FOV: 45 degrees.
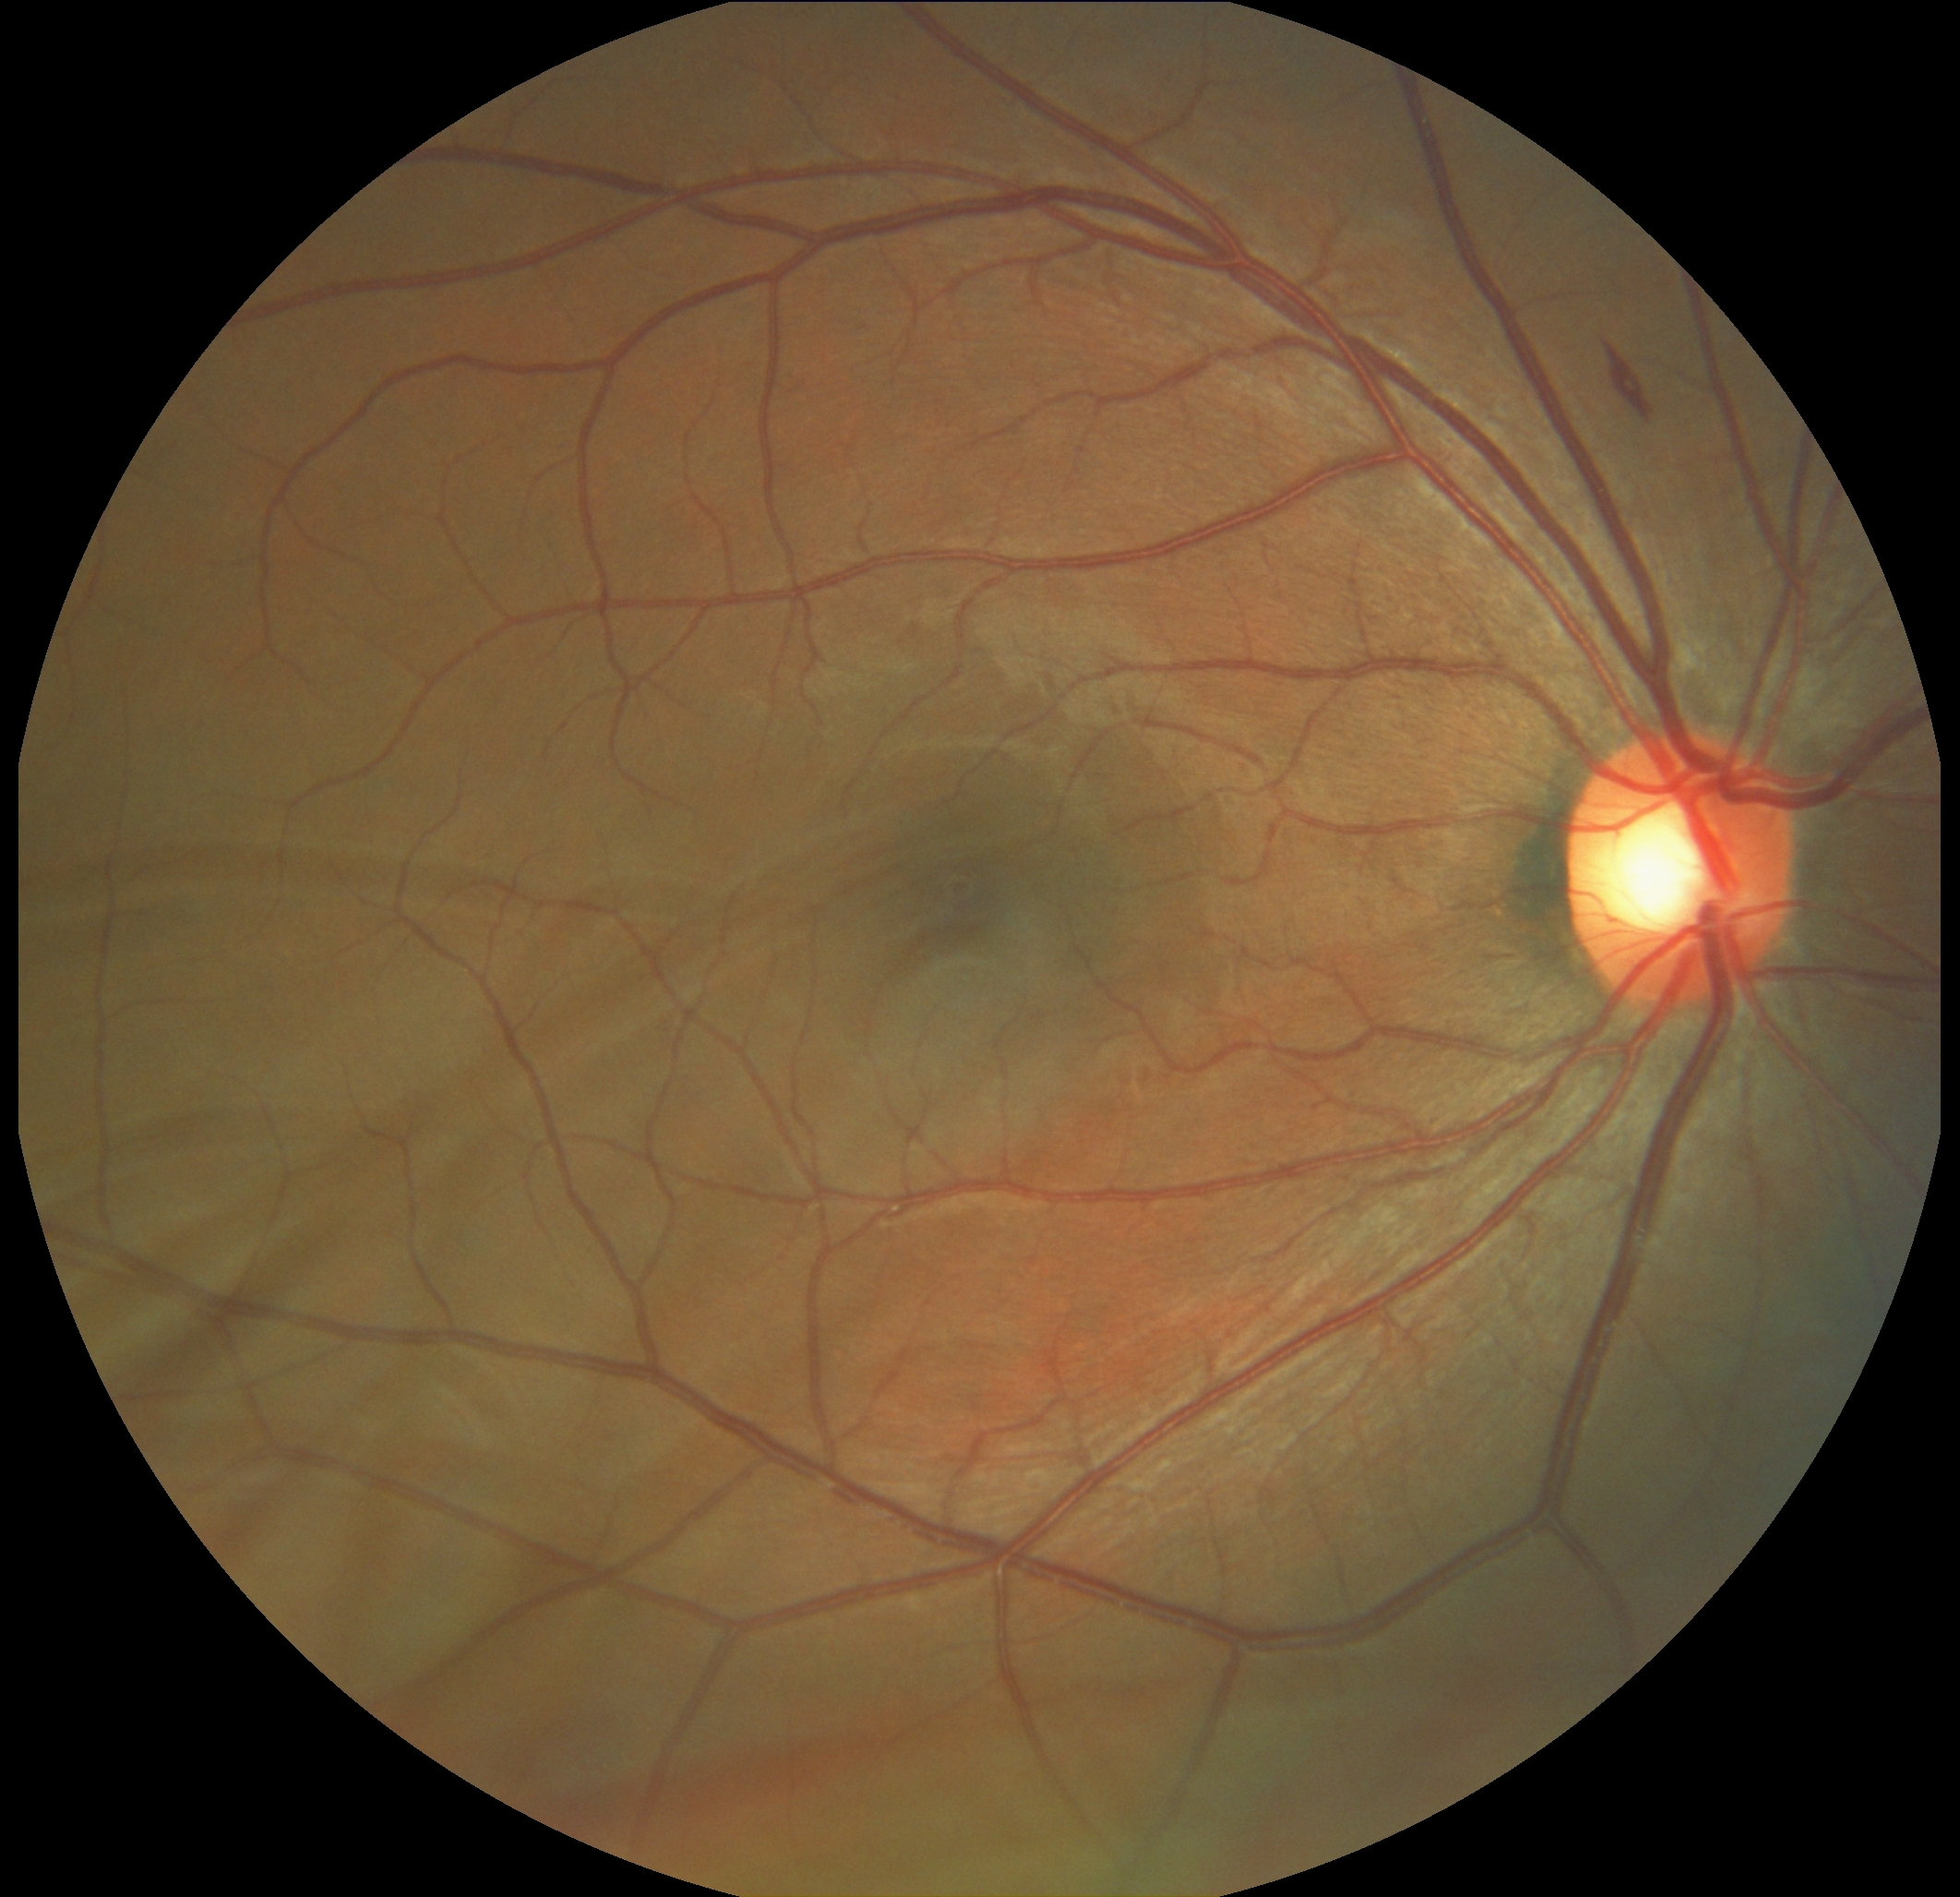 diabetic retinopathy (DR)=2 — more than just microaneurysms but less than severe NPDR, DR class=non-proliferative diabetic retinopathy.